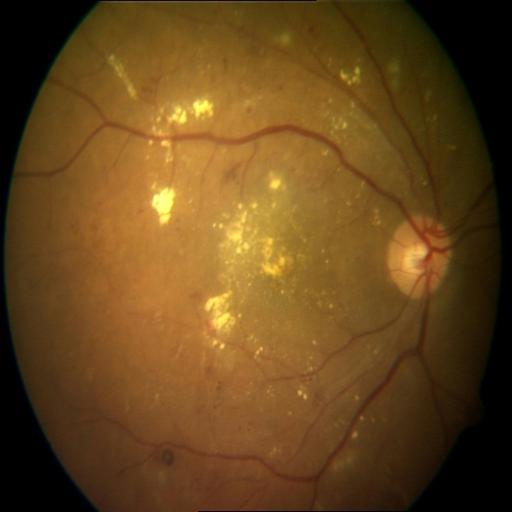

Demonstrates cystoid macular edema and exudation.